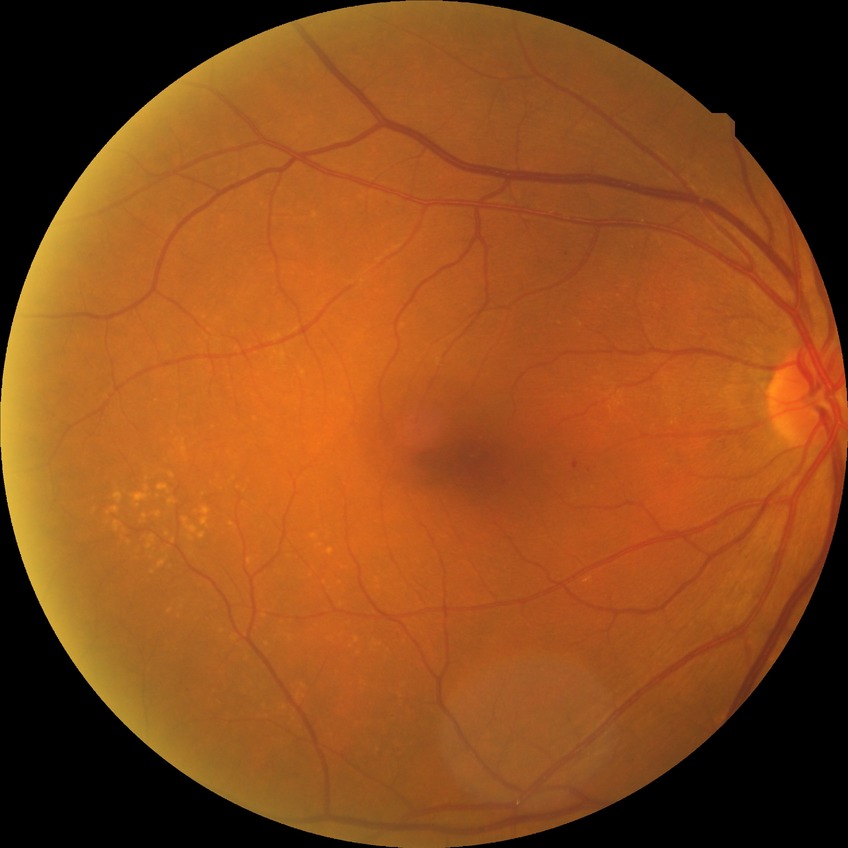

Assessment:
– diabetic retinopathy stage: no diabetic retinopathy